1536x1152px · color fundus photograph · 45-degree field of view — 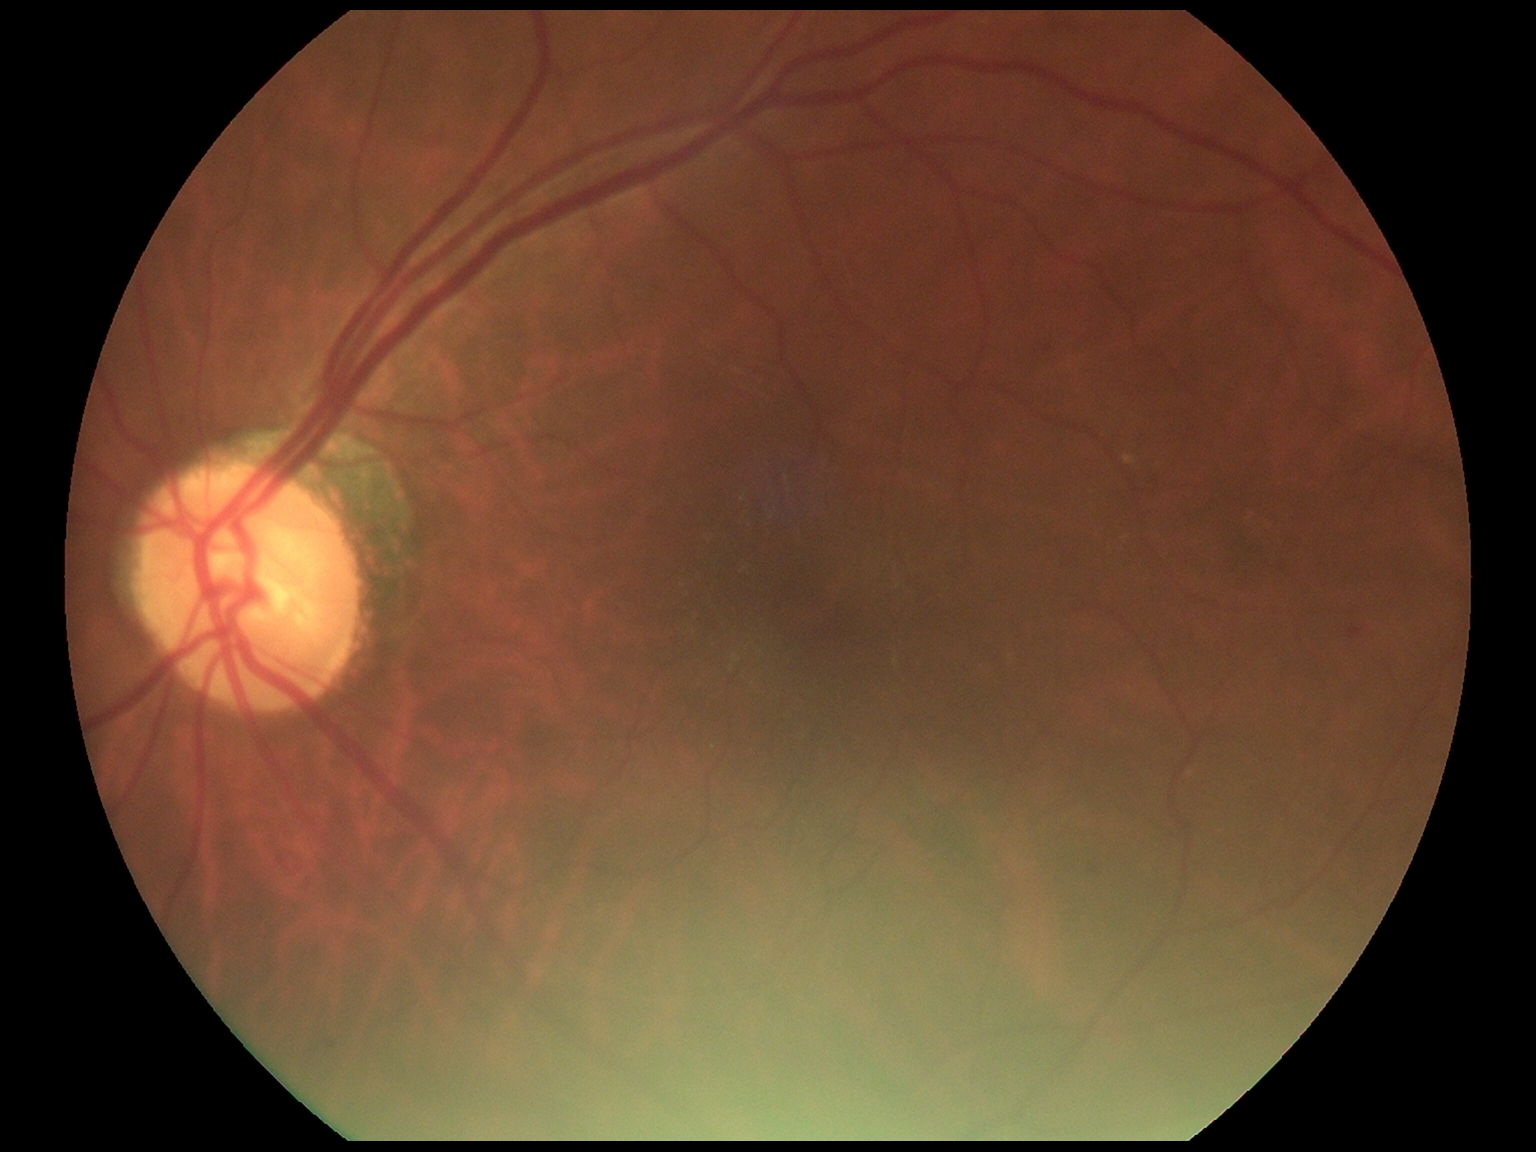

The retinopathy is classified as non-proliferative diabetic retinopathy.
DR severity is 2/4 — more than just microaneurysms but less than severe NPDR.